NIDEK AFC-230 fundus camera
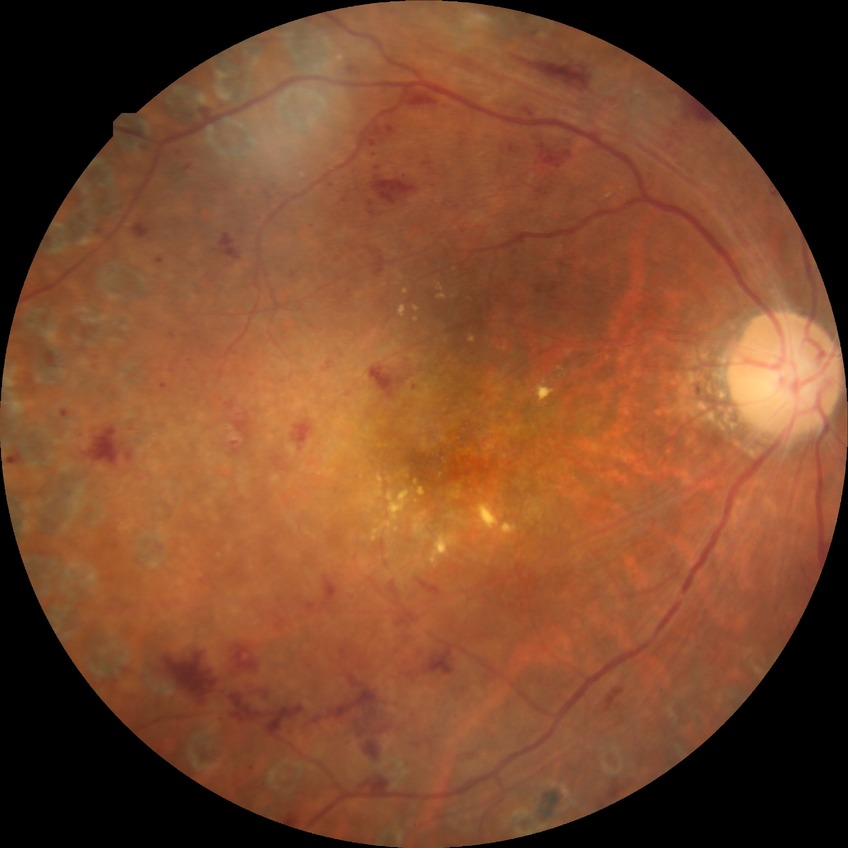

Diabetic retinopathy (DR) is PDR (proliferative diabetic retinopathy).